FOV: 45 degrees; Davis DR grading; retinal fundus photograph; without pupil dilation:
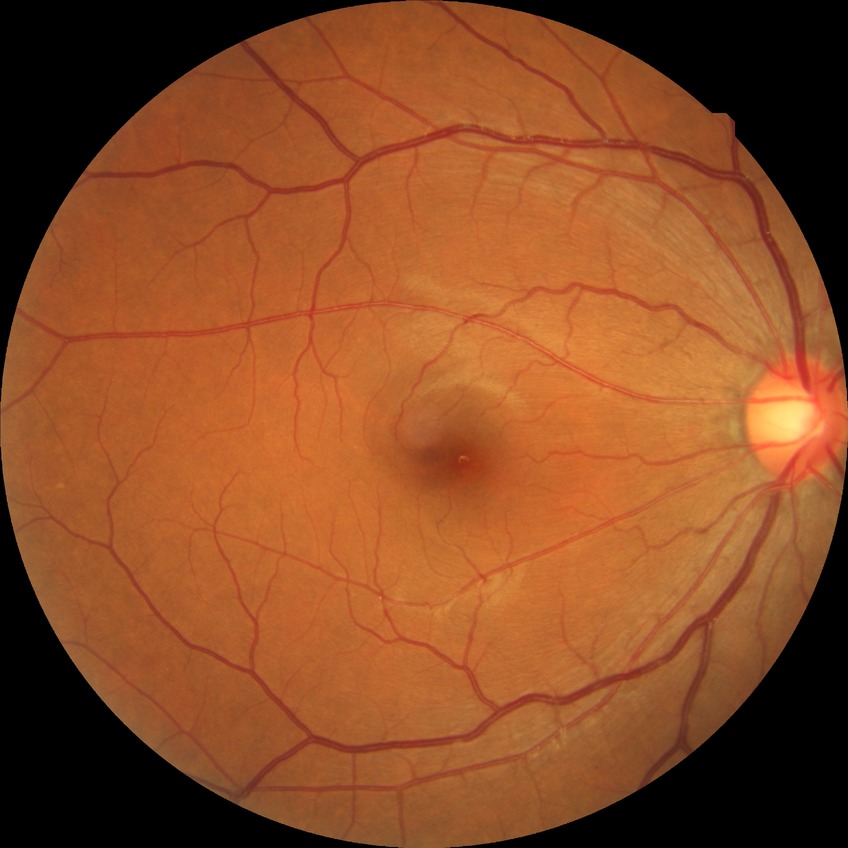 Davis stage: NDR.